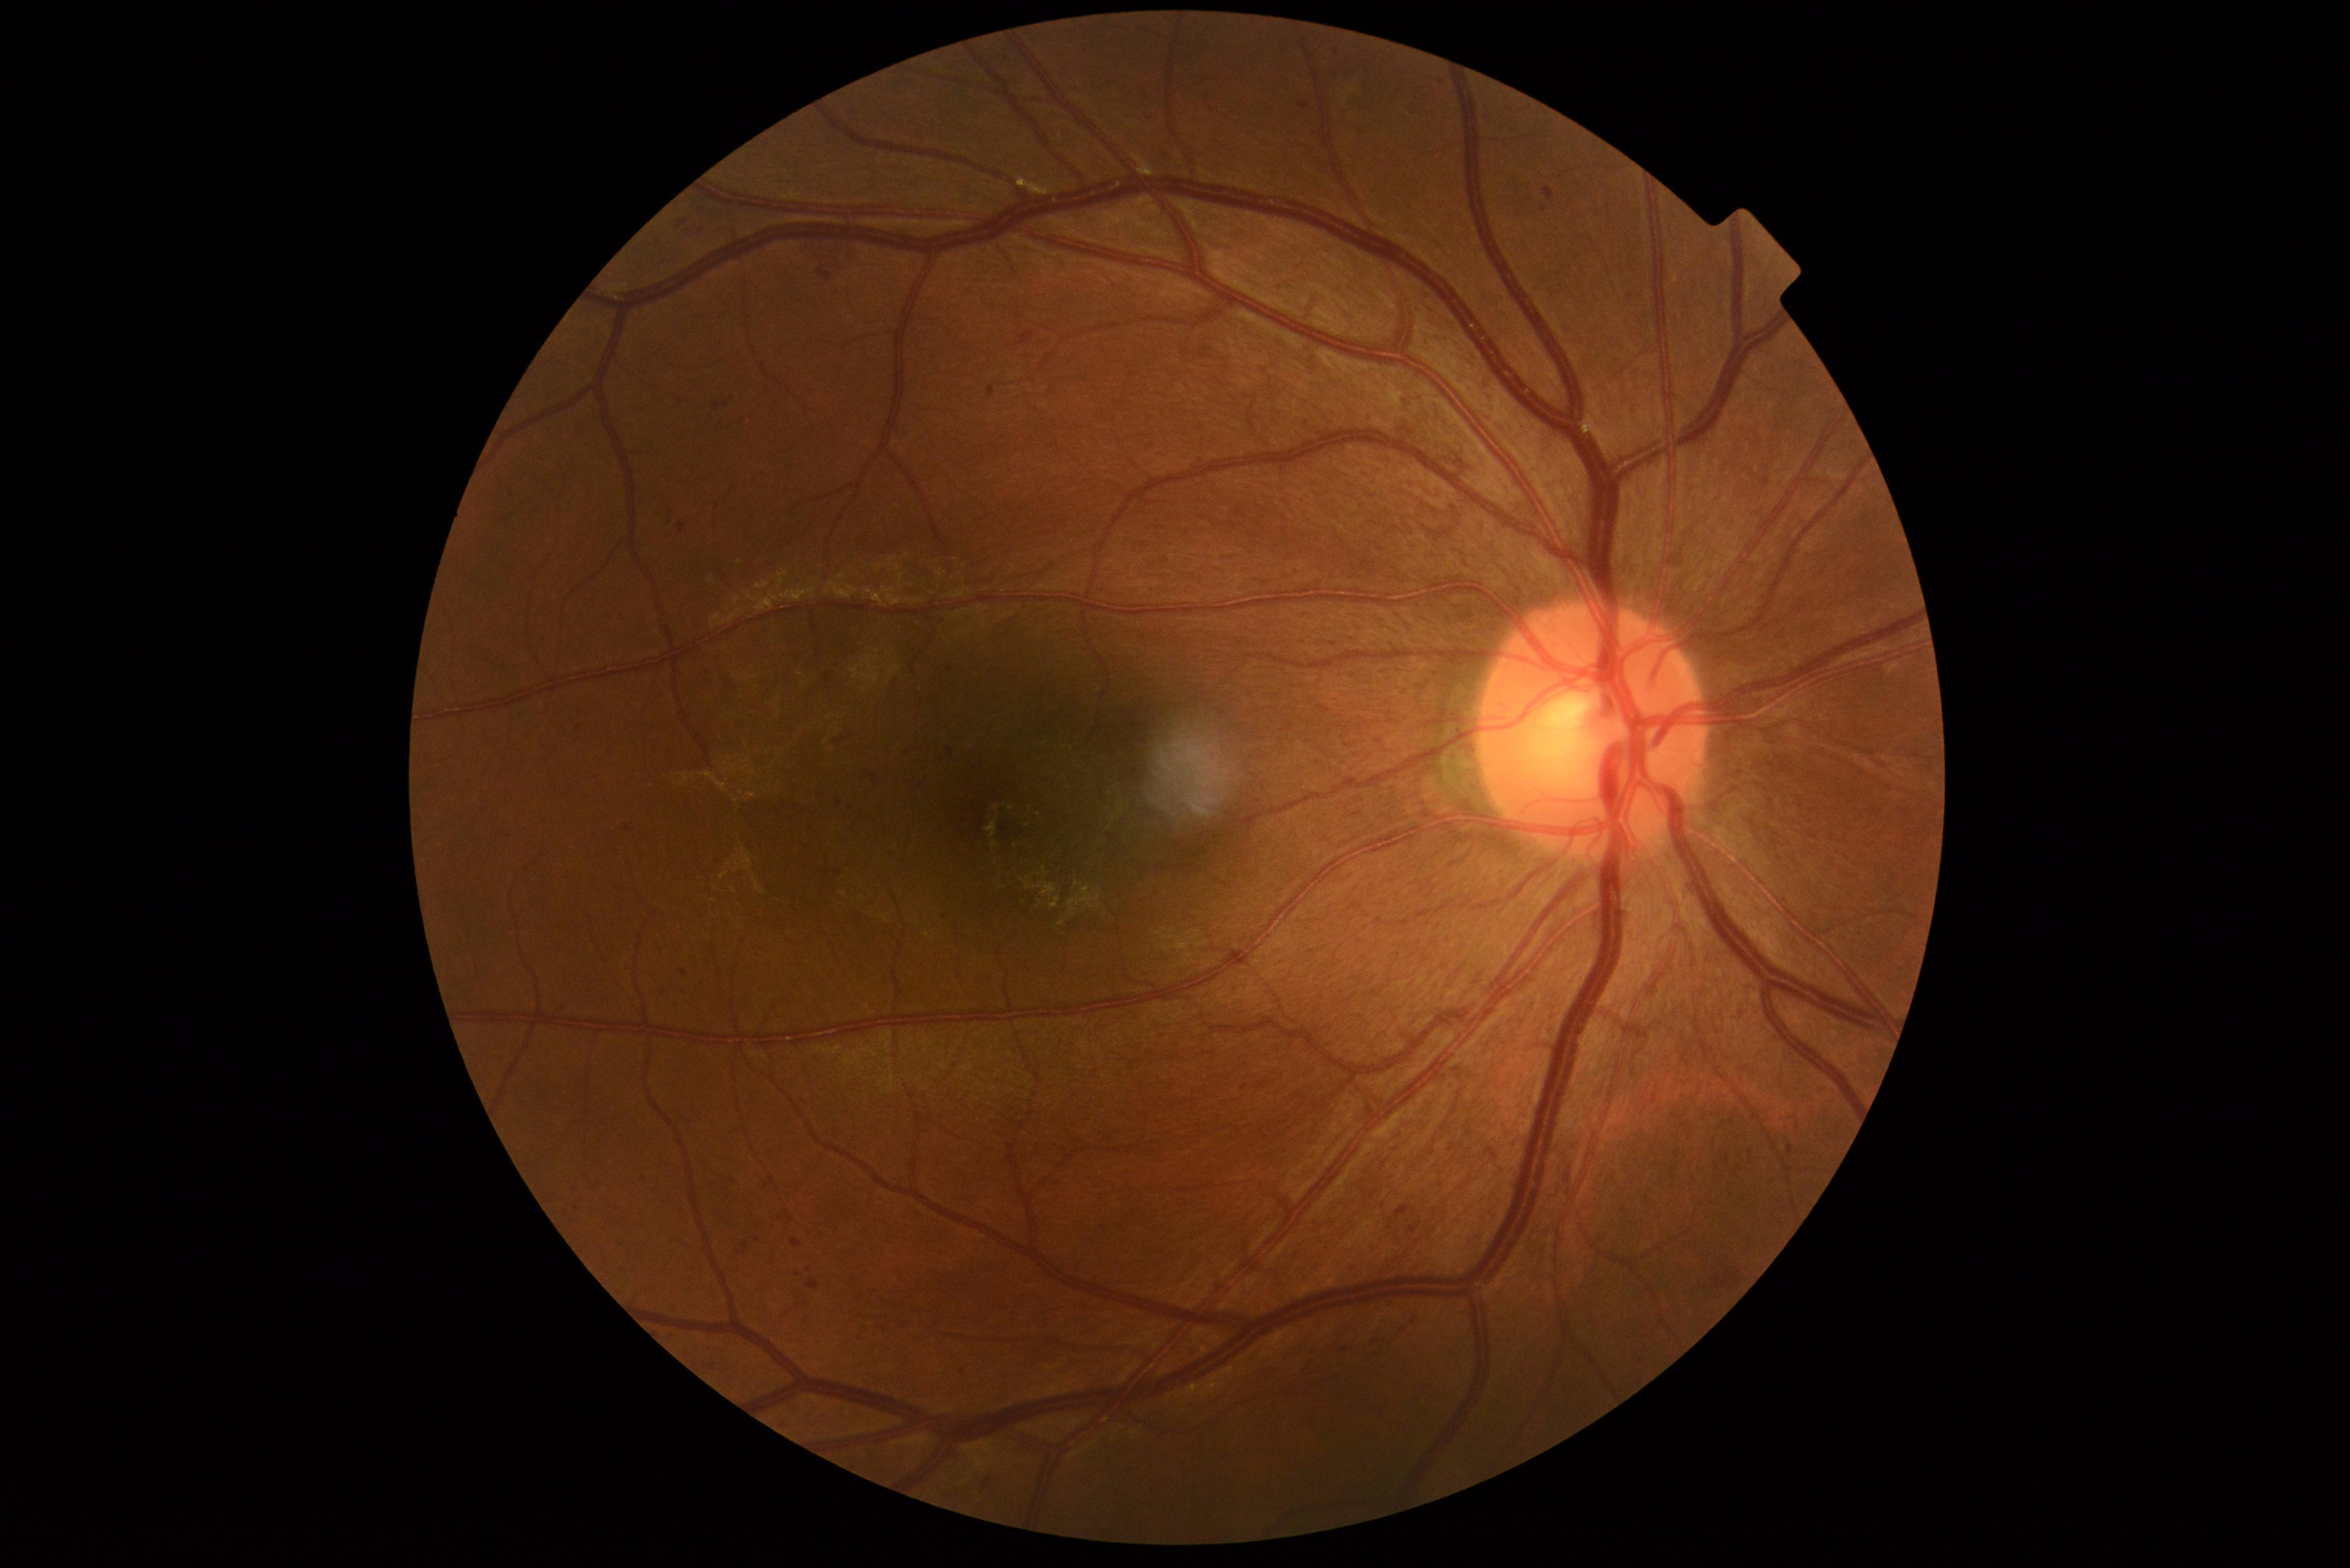
DR class: non-proliferative diabetic retinopathy. DR stage: grade 2.